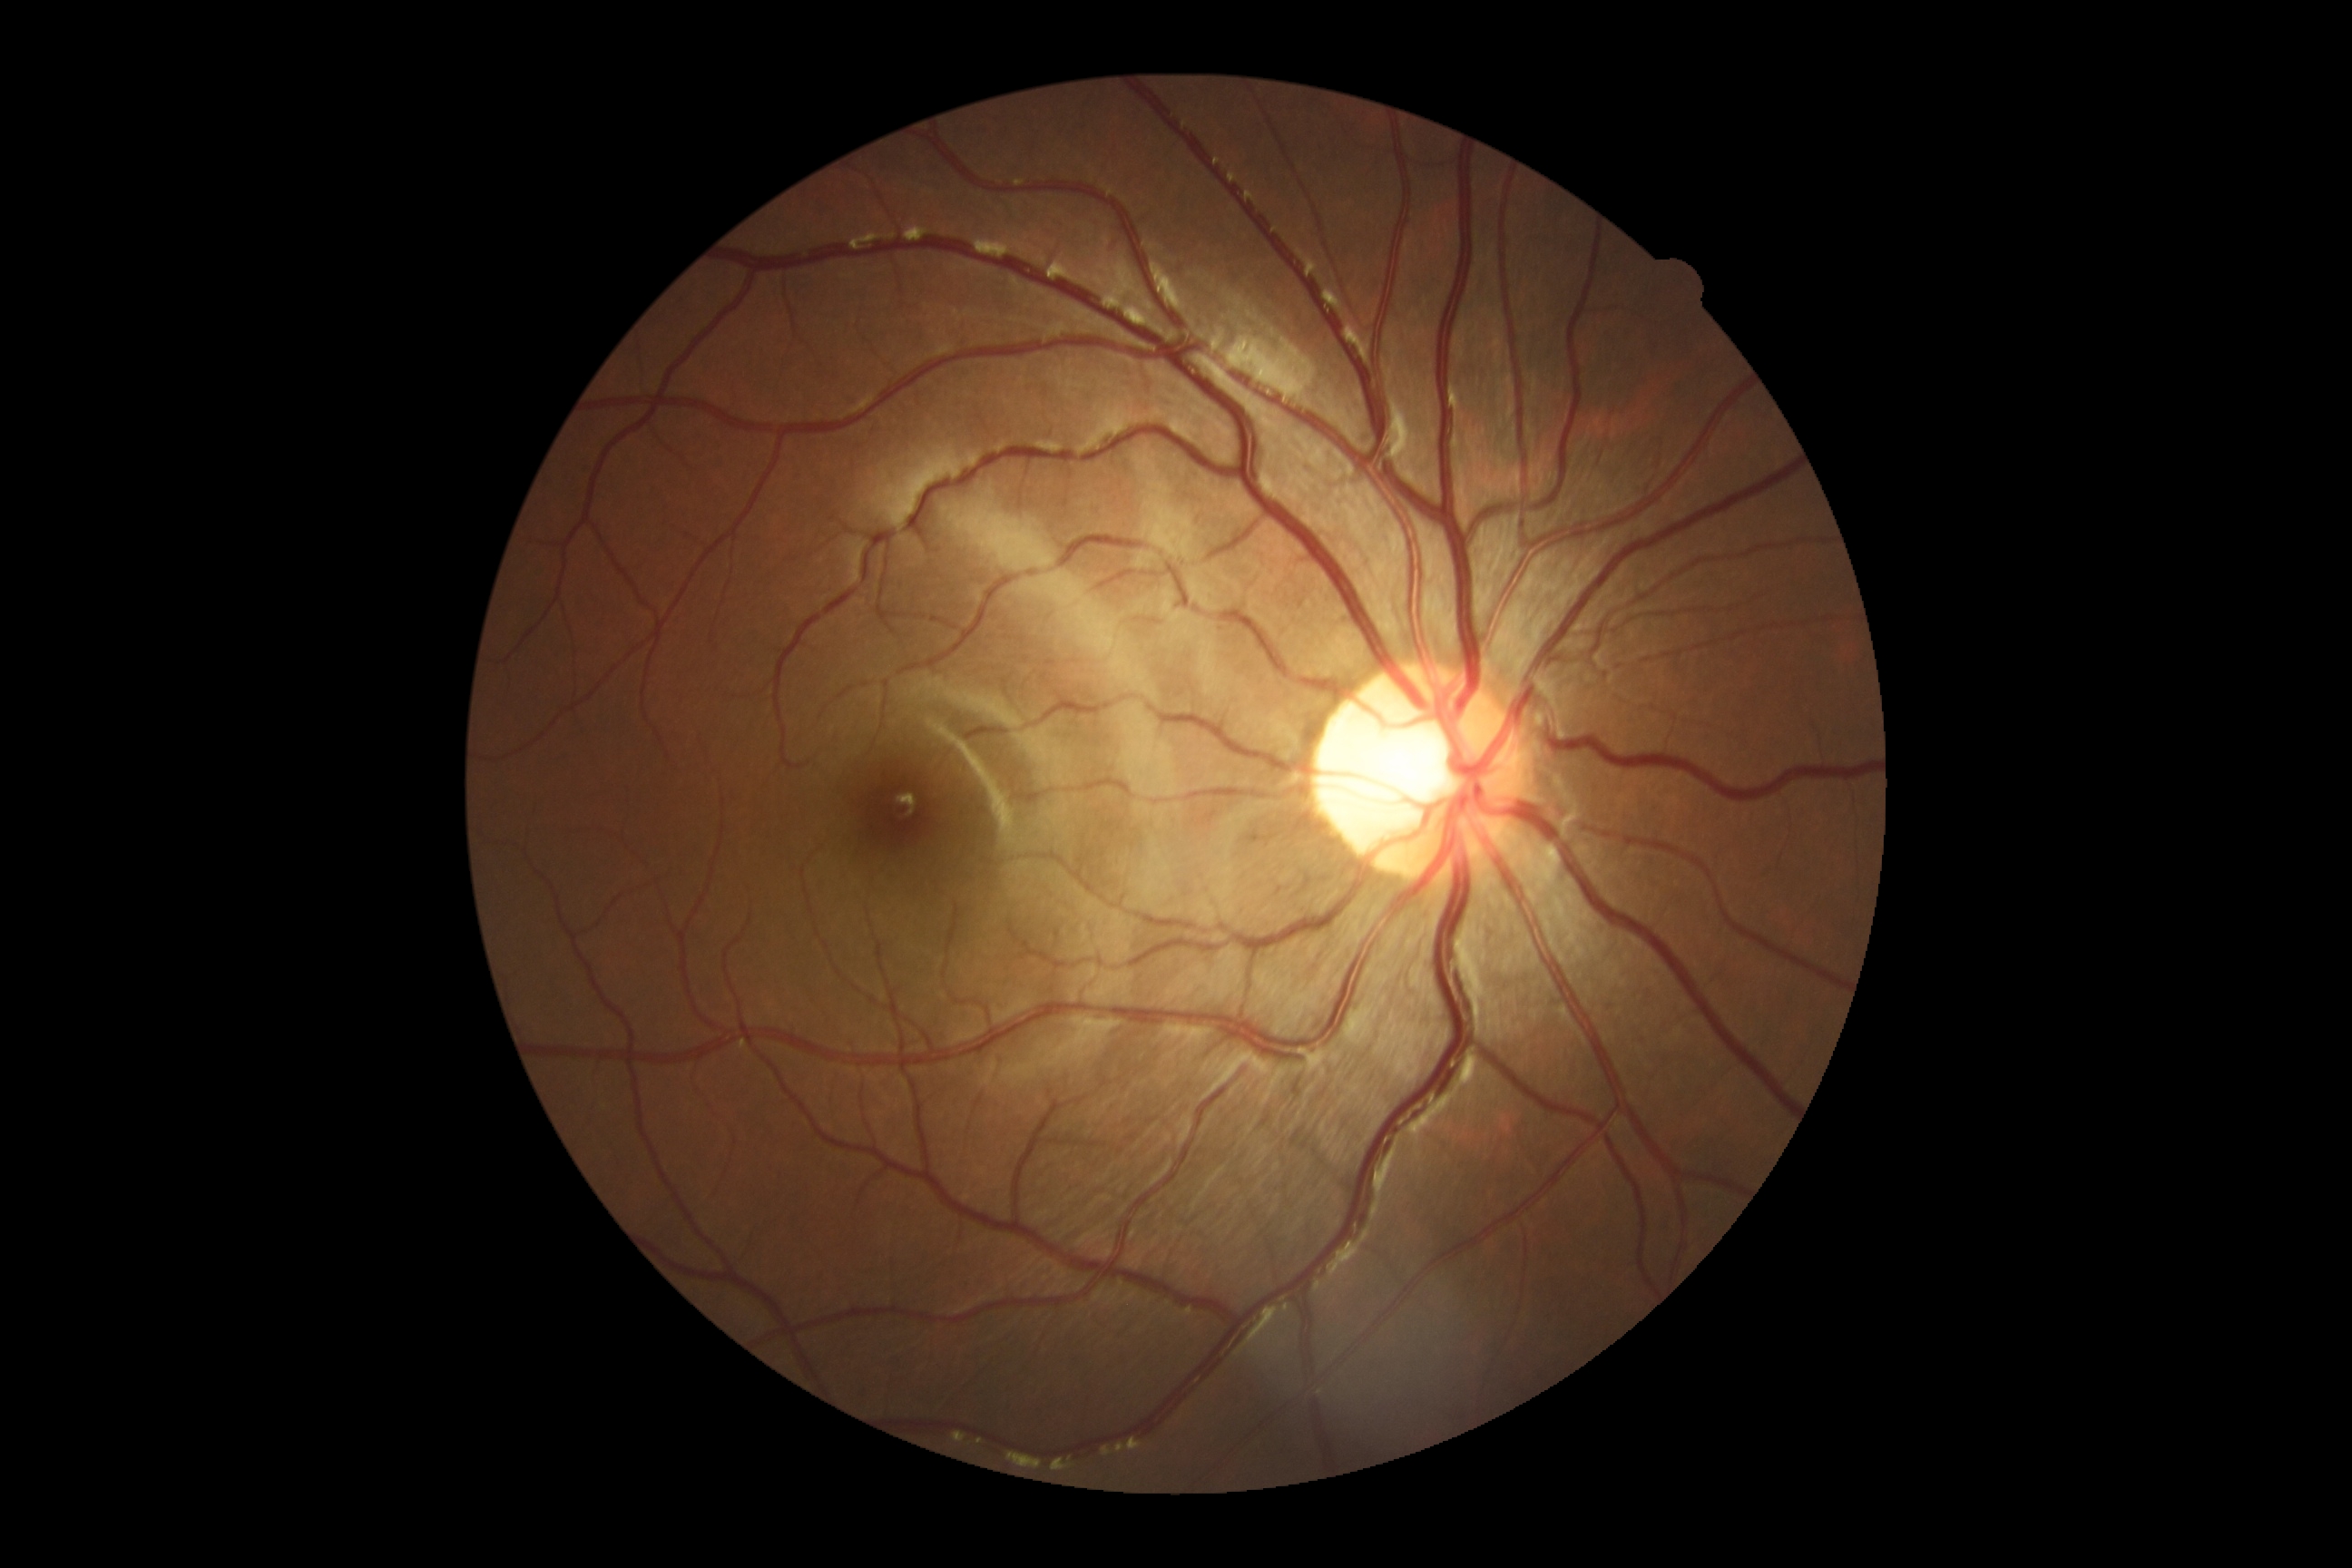 DR stage is no apparent diabetic retinopathy (grade 0) — no visible signs of diabetic retinopathy.